Posterior pole color fundus photograph: 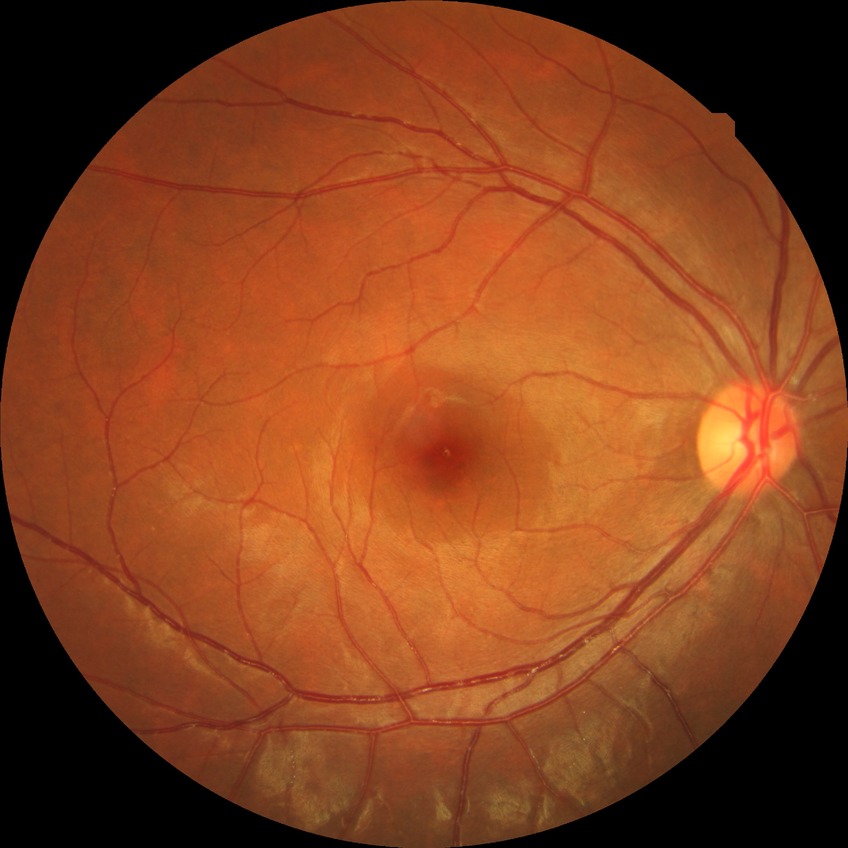

Diabetic retinopathy (DR): no diabetic retinopathy (NDR).